45° FOV — 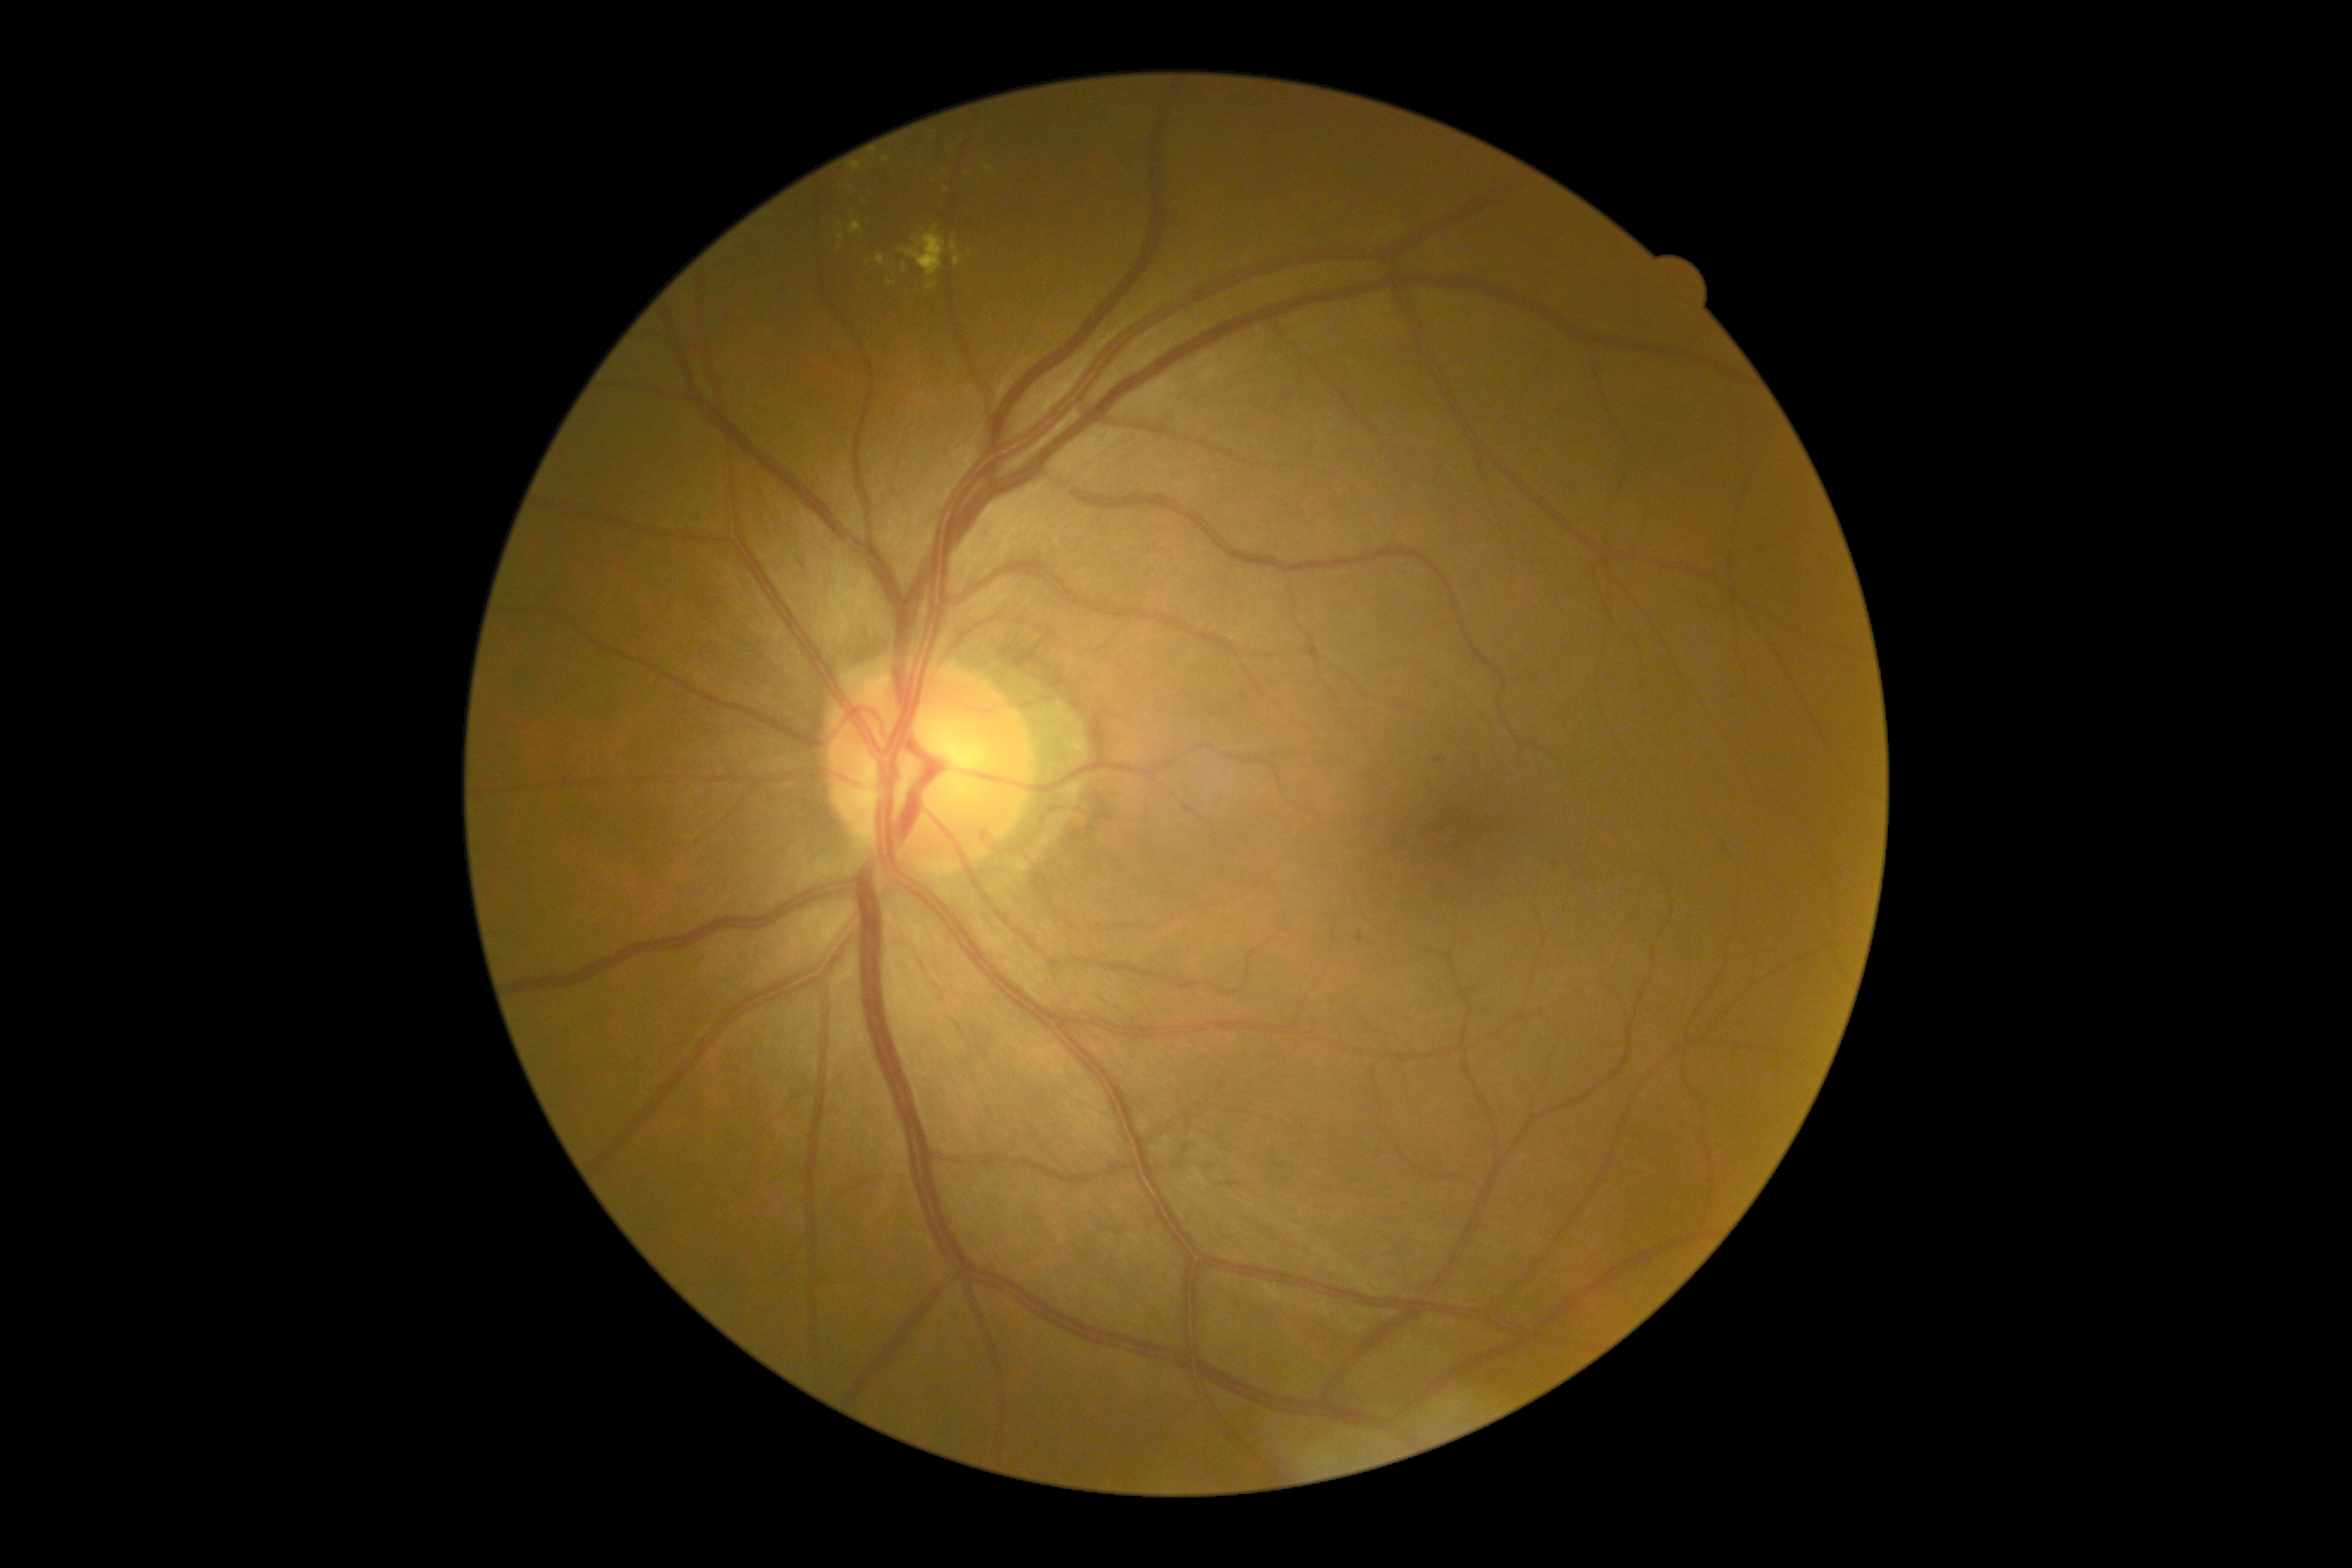 Diabetic retinopathy (DR) is grade 2.